Pediatric wide-field fundus photograph; captured with the Phoenix ICON (100° field of view); 1240 x 1240 pixels
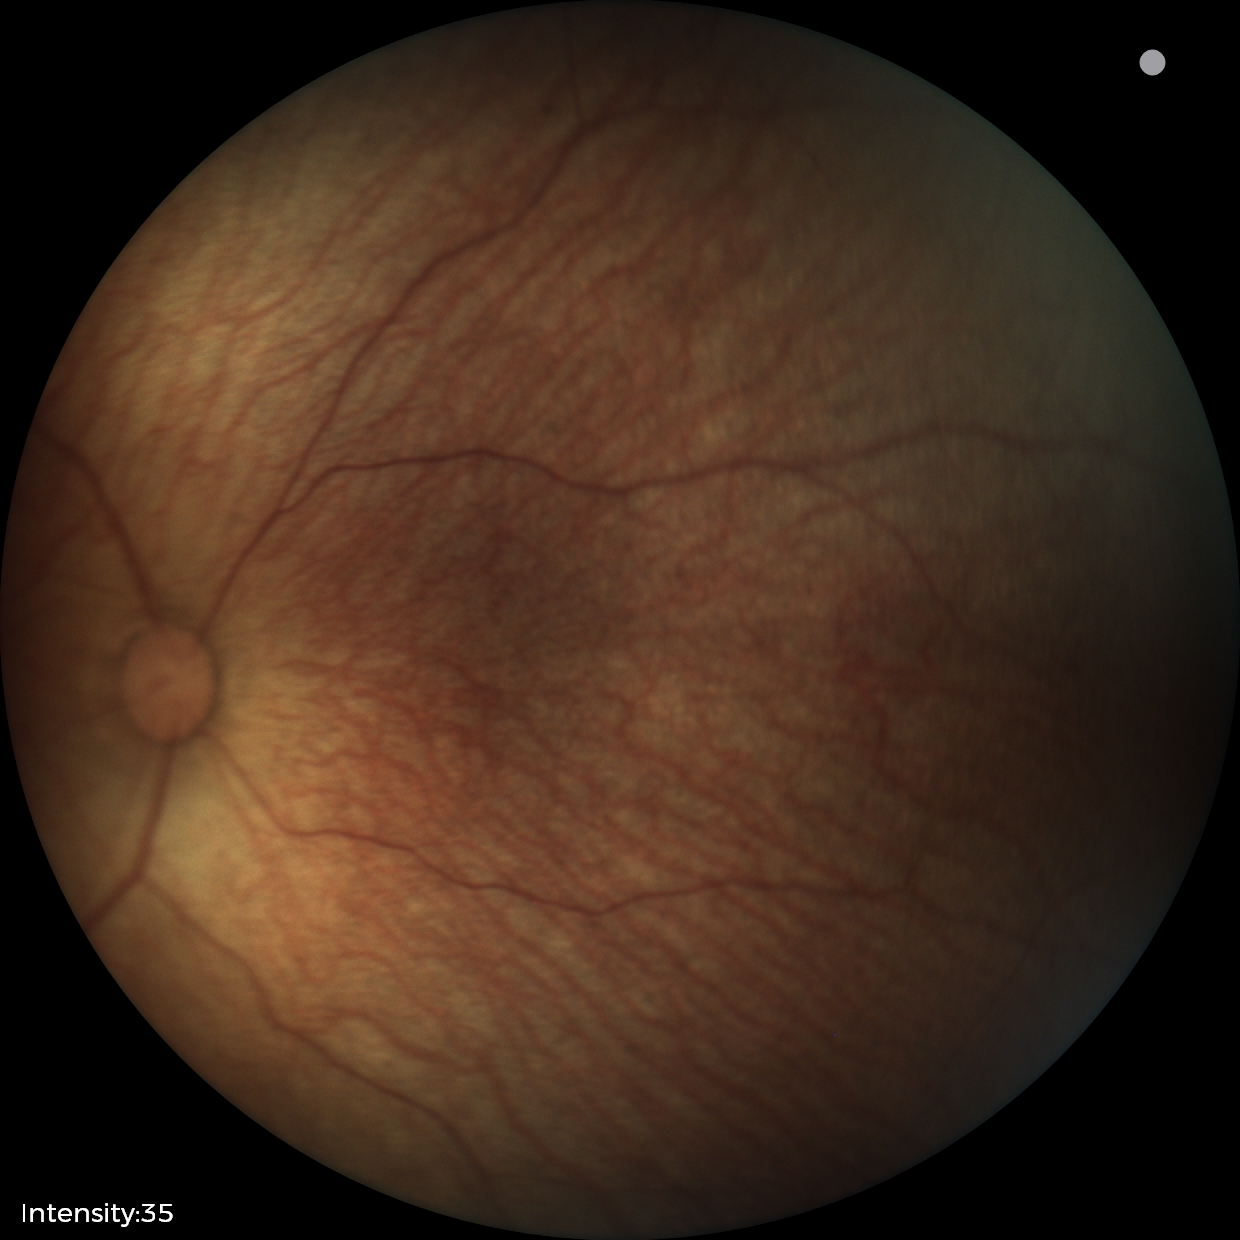 Screening diagnosis: no abnormal retinal findings.